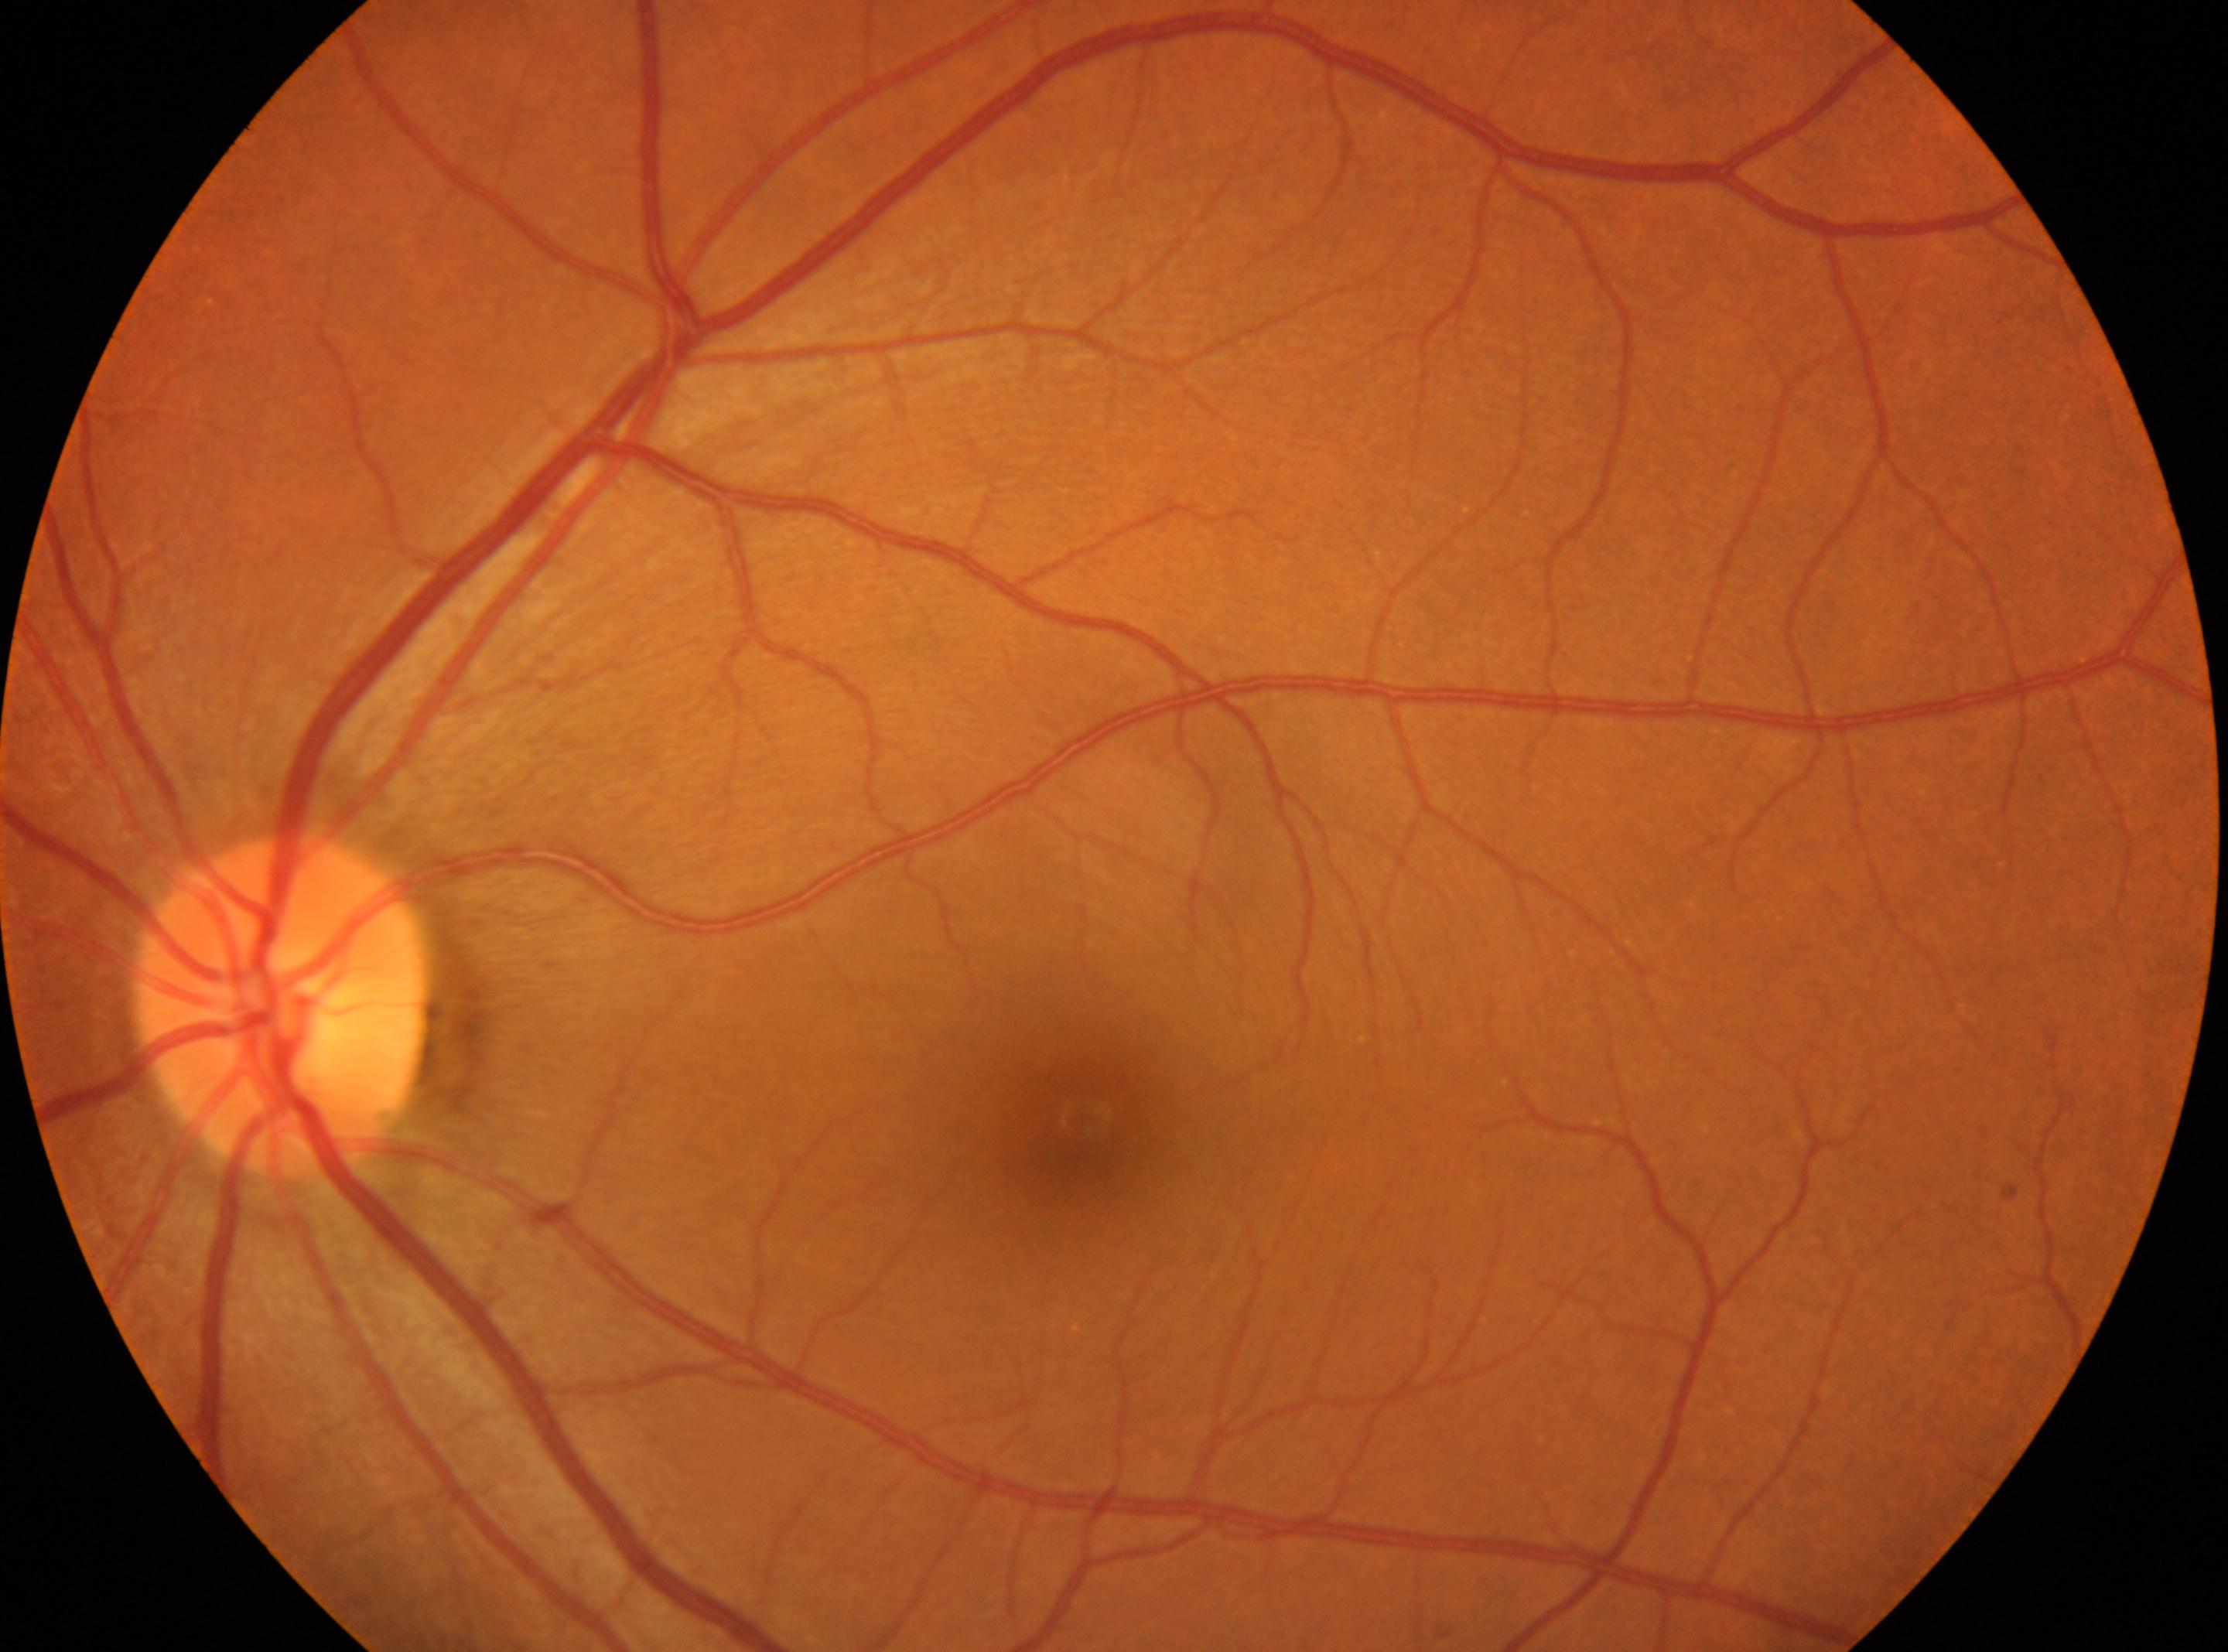
Imaged eye: OS.
The optic disc is at (x: 281, y: 1005).
Diabetic retinopathy grade is 0.
Fovea centralis located at (x: 1083, y: 1120).
No diabetic retinopathy identified.